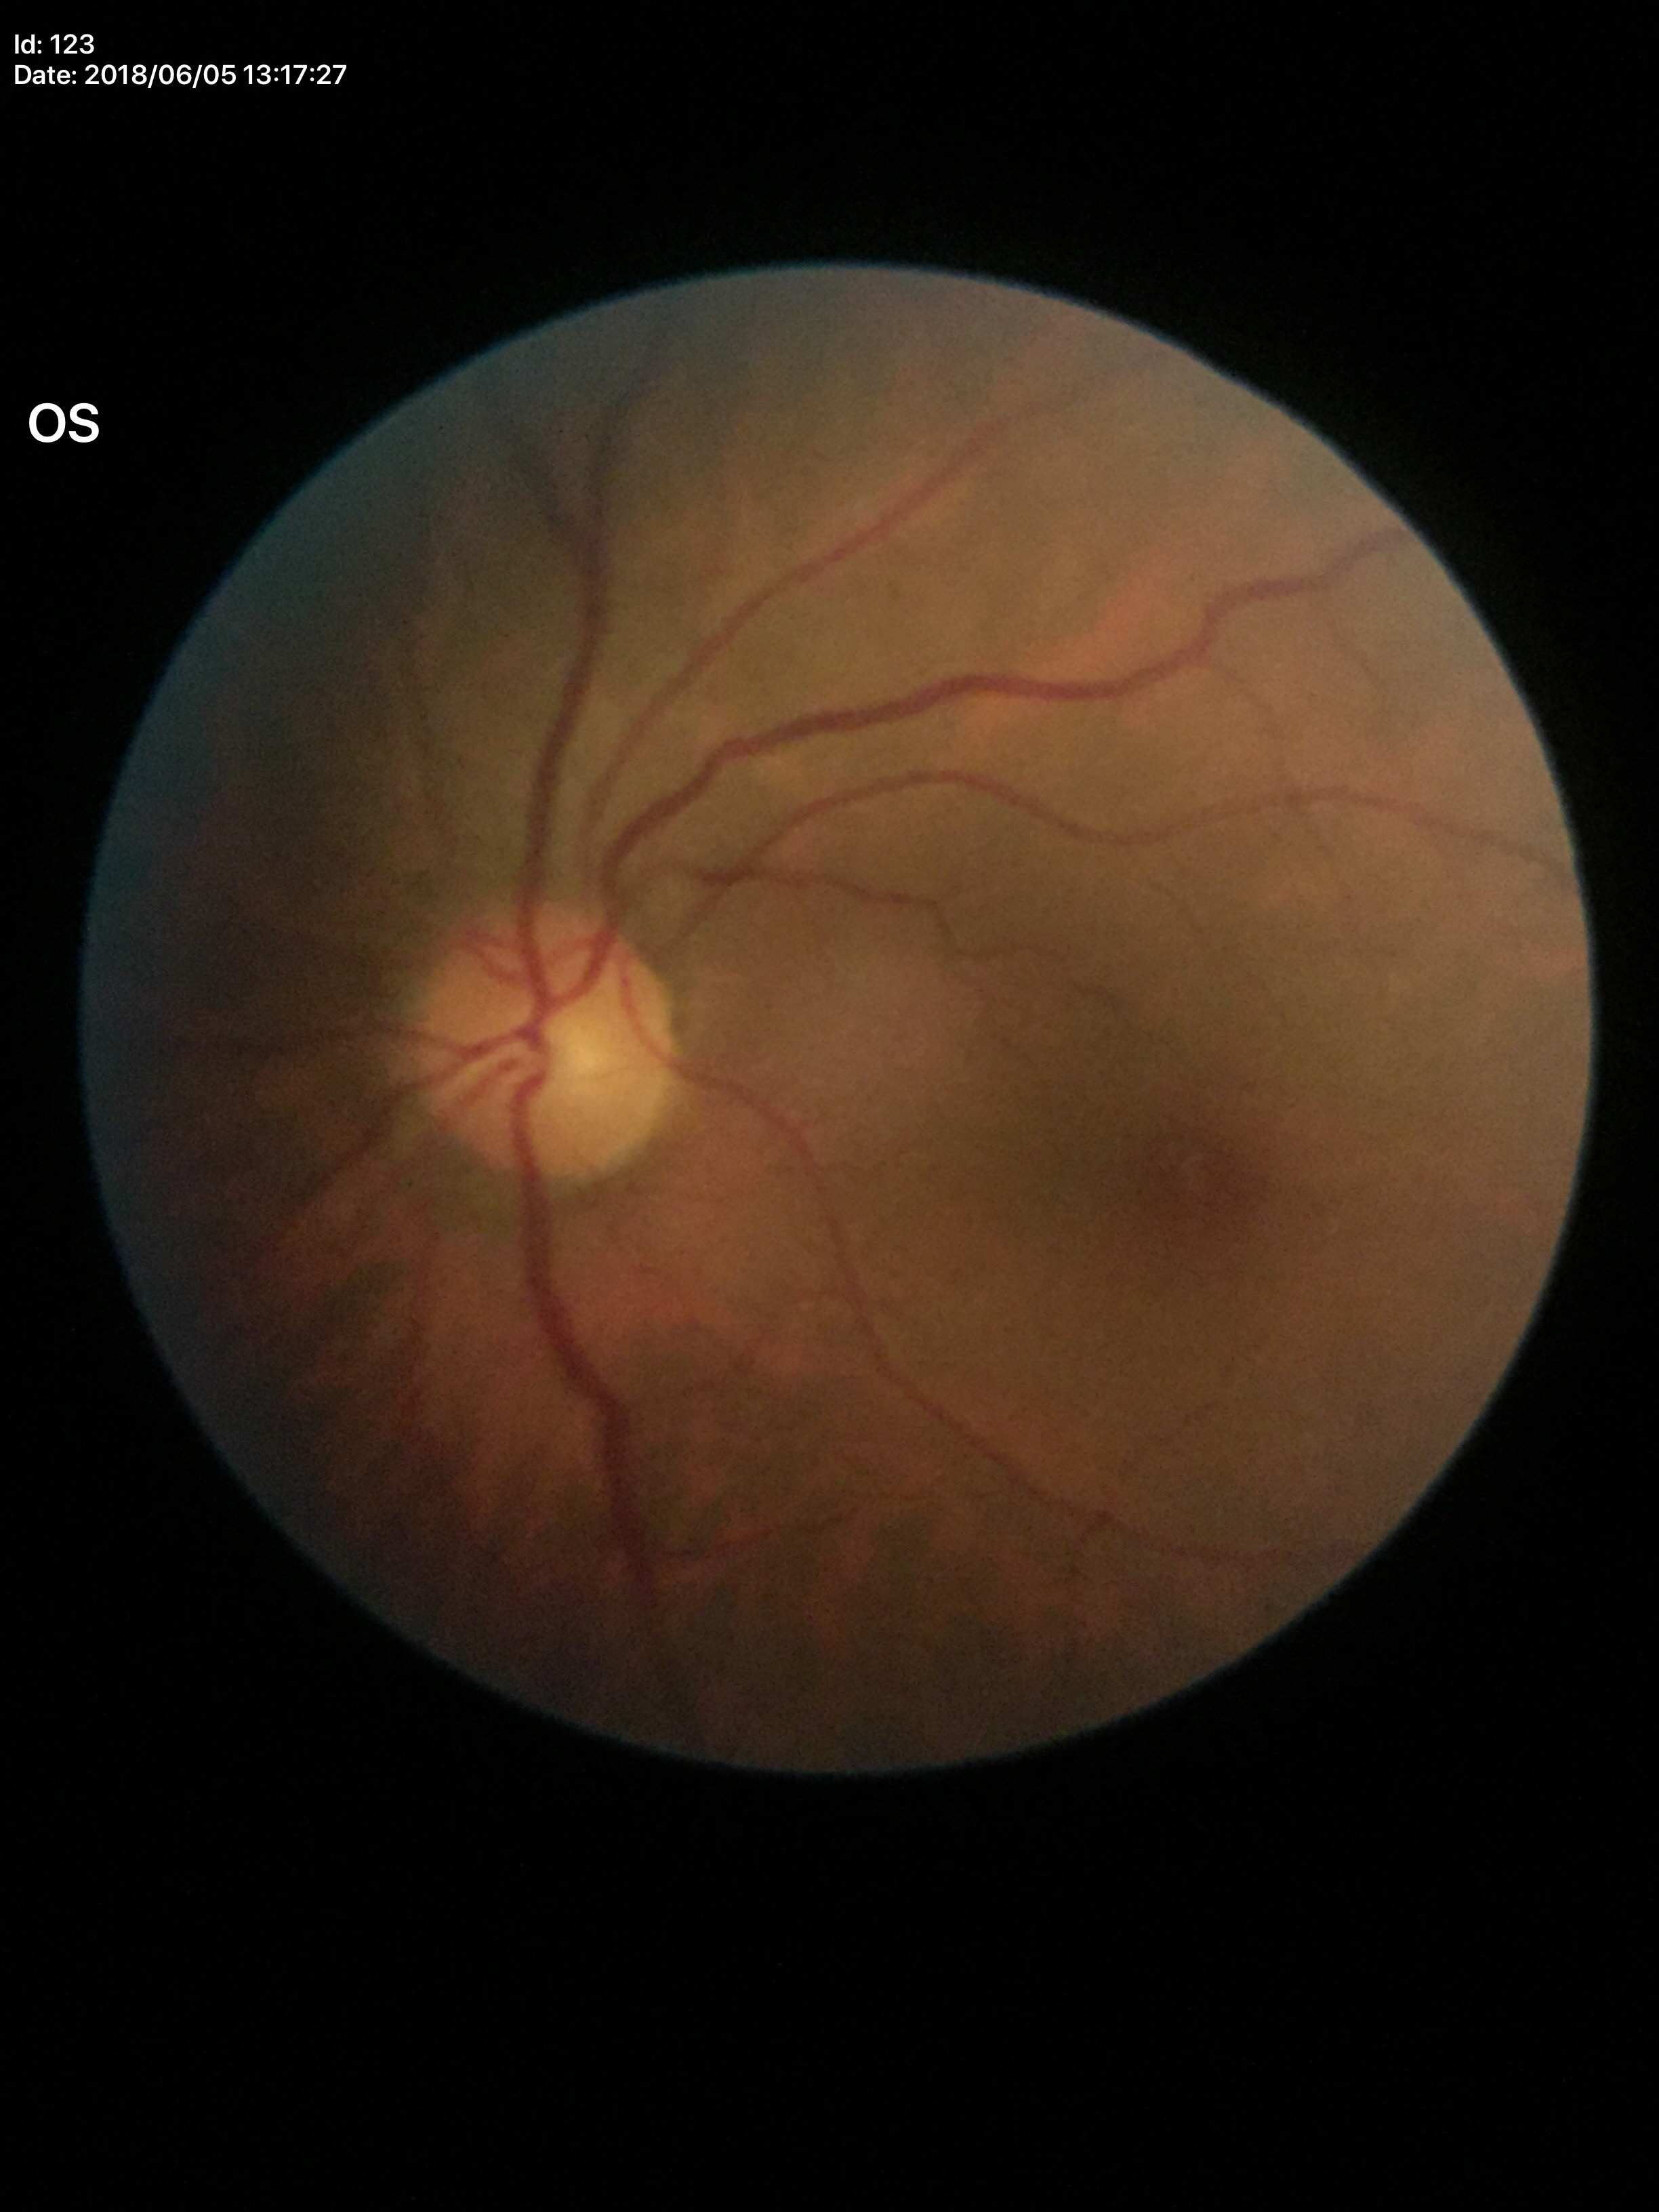 No glaucomatous optic neuropathy.
Vertical CDR is 0.45.
Horizontal cup-to-disc ratio: 0.45.
Area cup-disc ratio of 0.20.